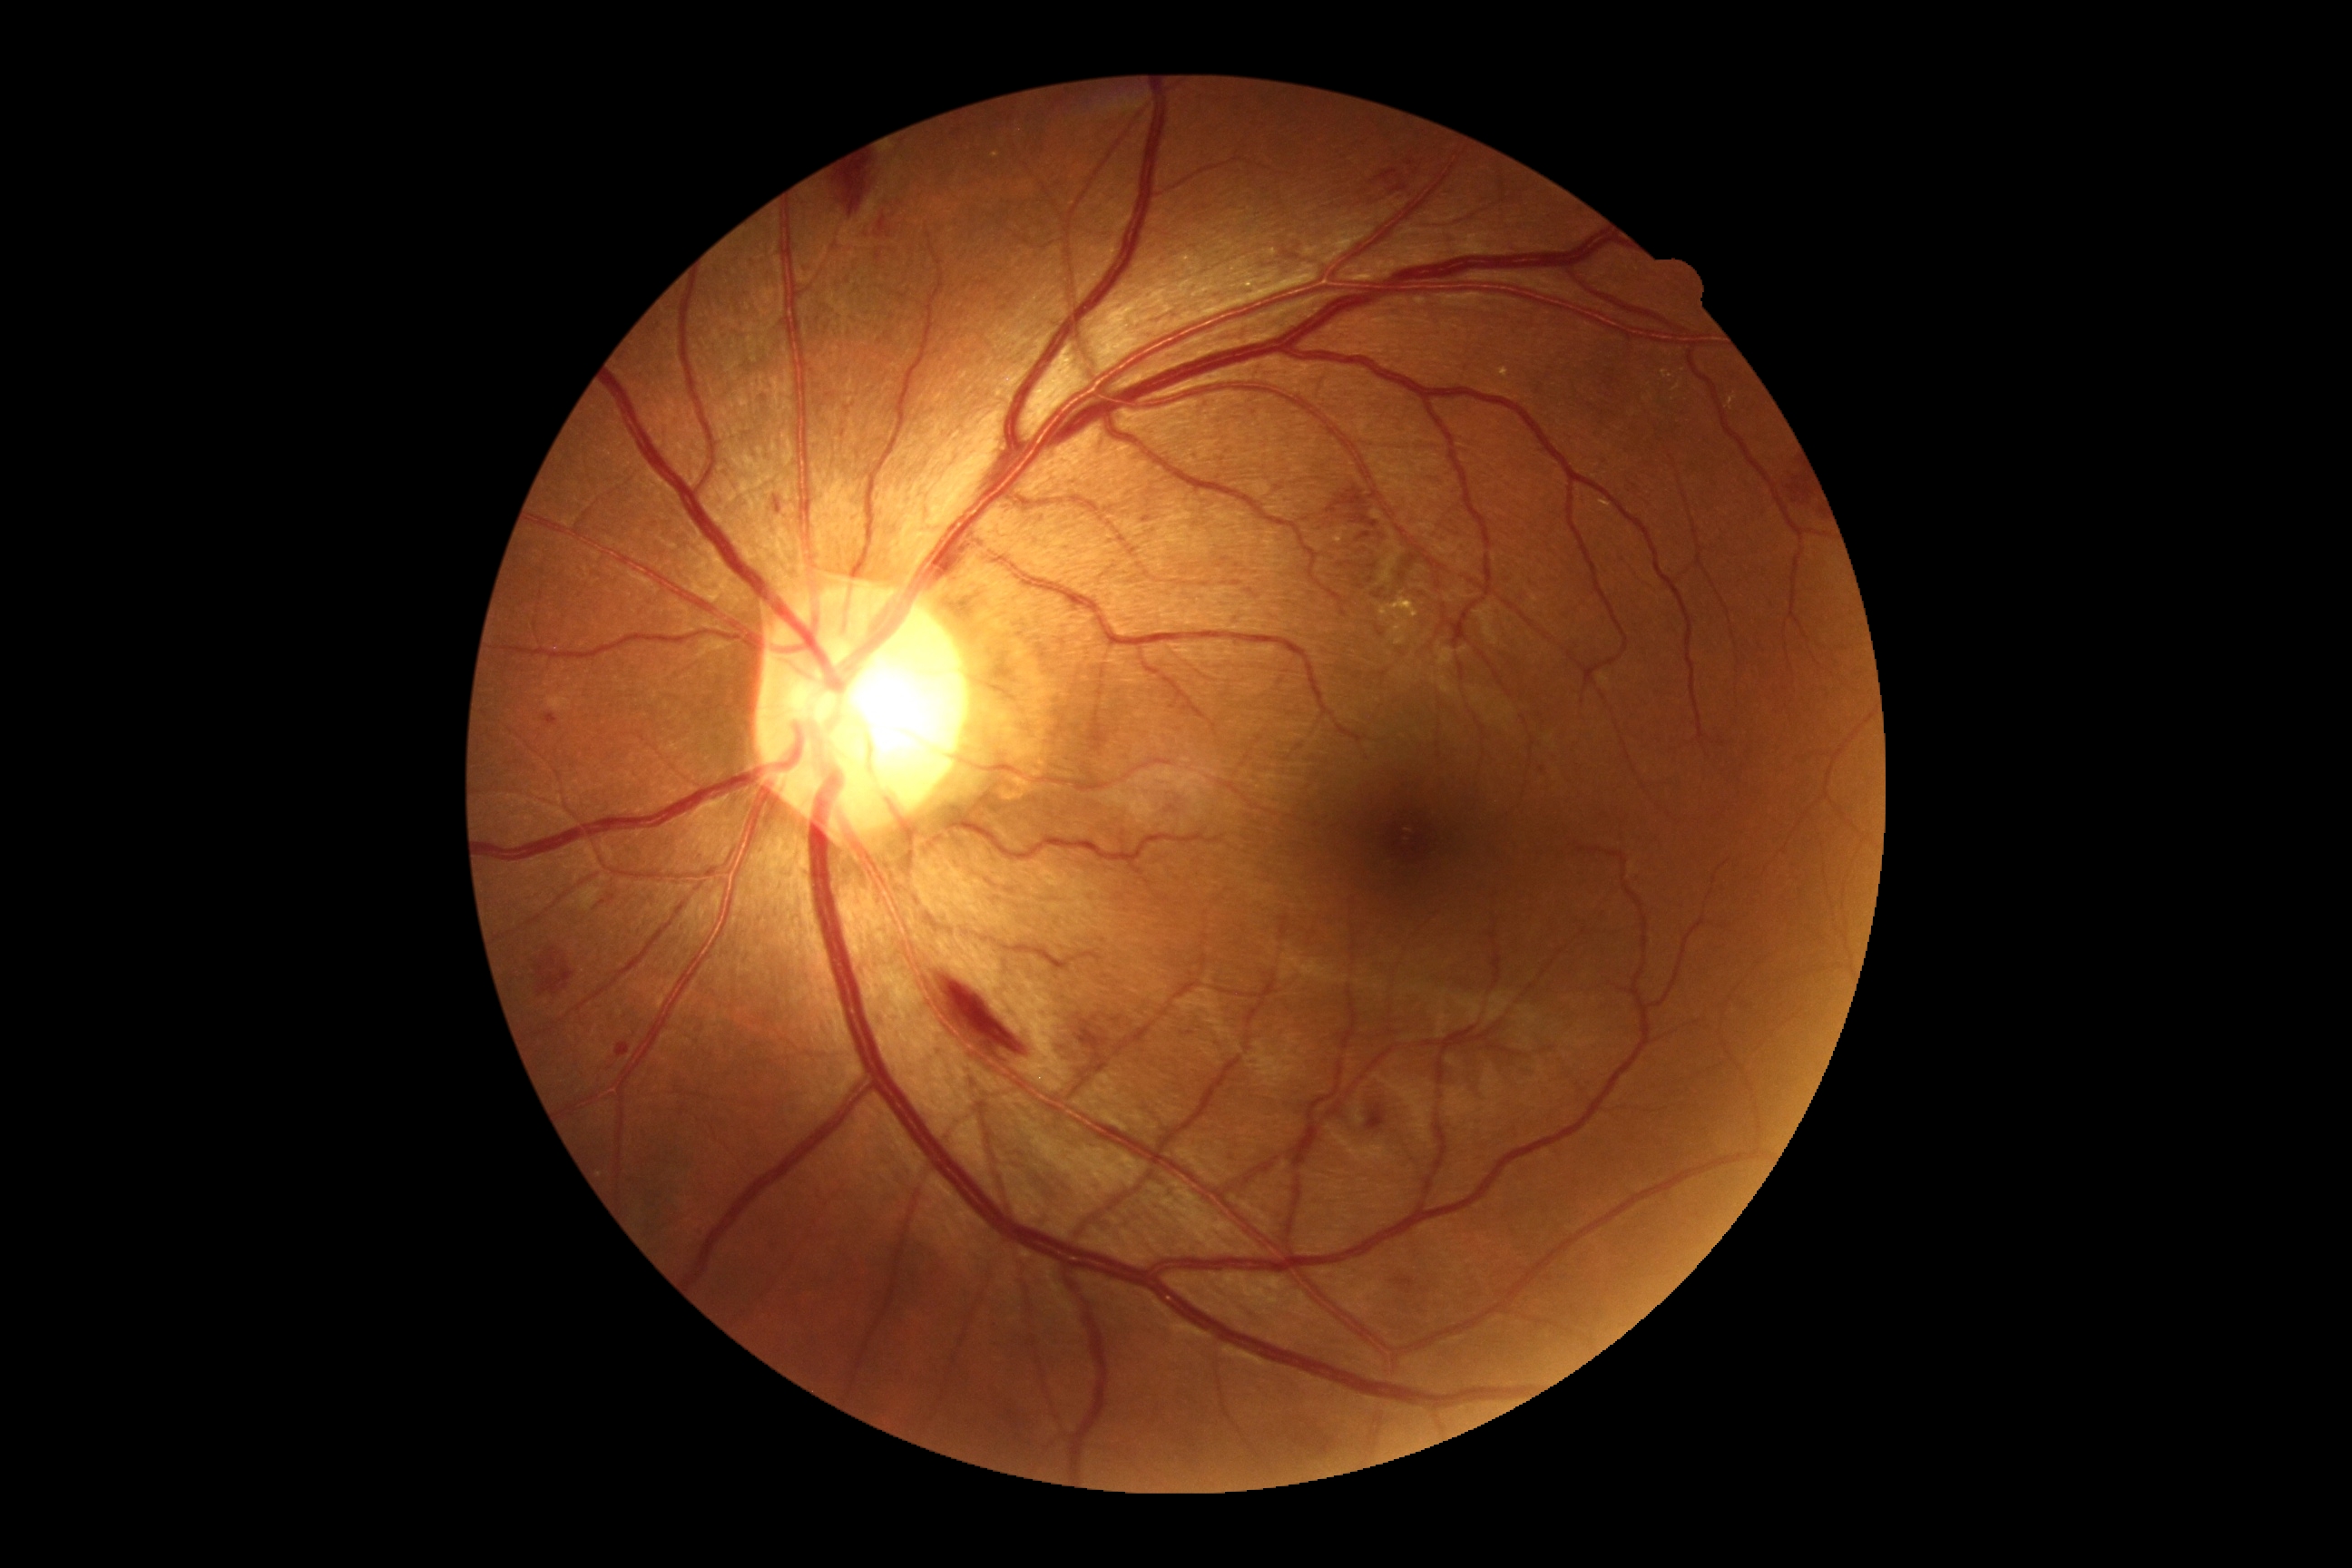 partial: true
dr_grade: 2
dr_grade_name: moderate NPDR
lesions:
  se:
    - l=861, t=182, r=887, b=226
  ex:
    - l=1380, t=593, r=1420, b=622
    - l=1672, t=382, r=1681, b=391
    - l=1661, t=369, r=1672, b=380
    - l=1727, t=395, r=1738, b=409
    - l=1498, t=368, r=1509, b=378
    - l=1331, t=527, r=1349, b=545
    - l=1600, t=500, r=1612, b=511
  ex_small_centers:
    - [1674,400]
    - [995,156]
  he:
    - l=1298, t=485, r=1400, b=600
    - l=1072, t=1014, r=1110, b=1097
    - l=1779, t=456, r=1818, b=516
    - l=770, t=493, r=783, b=516
    - l=937, t=974, r=1028, b=1059
    - l=1112, t=1017, r=1122, b=1023
    - l=534, t=948, r=578, b=1001
    - l=1393, t=1277, r=1416, b=1295
    - l=593, t=901, r=607, b=910
    - l=544, t=712, r=558, b=725
    - l=614, t=1039, r=631, b=1061
    - l=1373, t=553, r=1431, b=603
    - l=876, t=250, r=883, b=262
    - l=799, t=262, r=819, b=280
    - l=876, t=217, r=892, b=239
    - l=839, t=162, r=872, b=217
    - l=1366, t=1104, r=1387, b=1132
  he_small_centers:
    - [612,899]
  ma: []